RetCam wide-field infant fundus image. 640 x 480 pixels
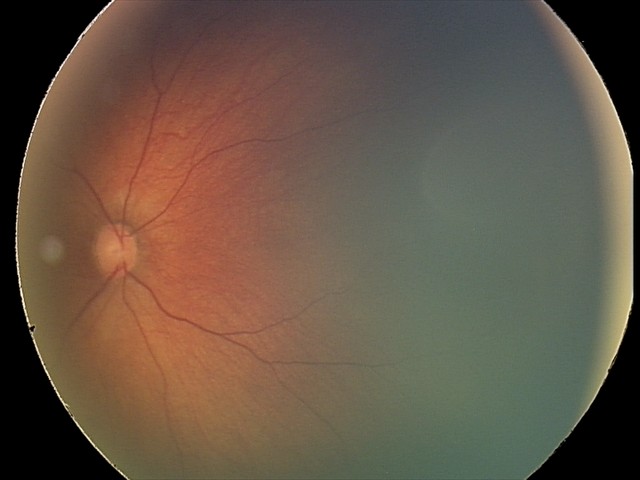 From an examination with diagnosis of retinal hemorrhages.